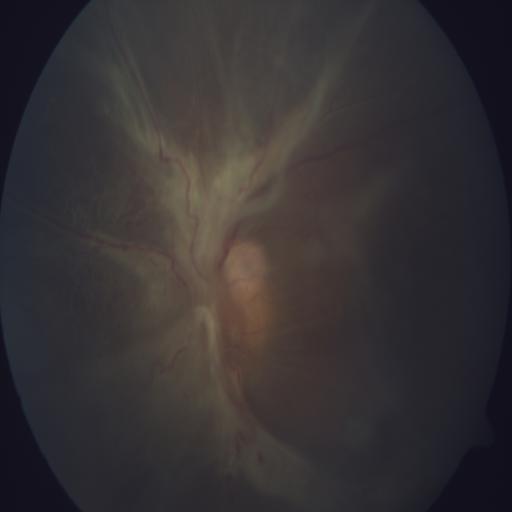

Findings: retinal detachment.